45° field of view · diabetic retinopathy graded by the modified Davis classification · NIDEK AFC-230.
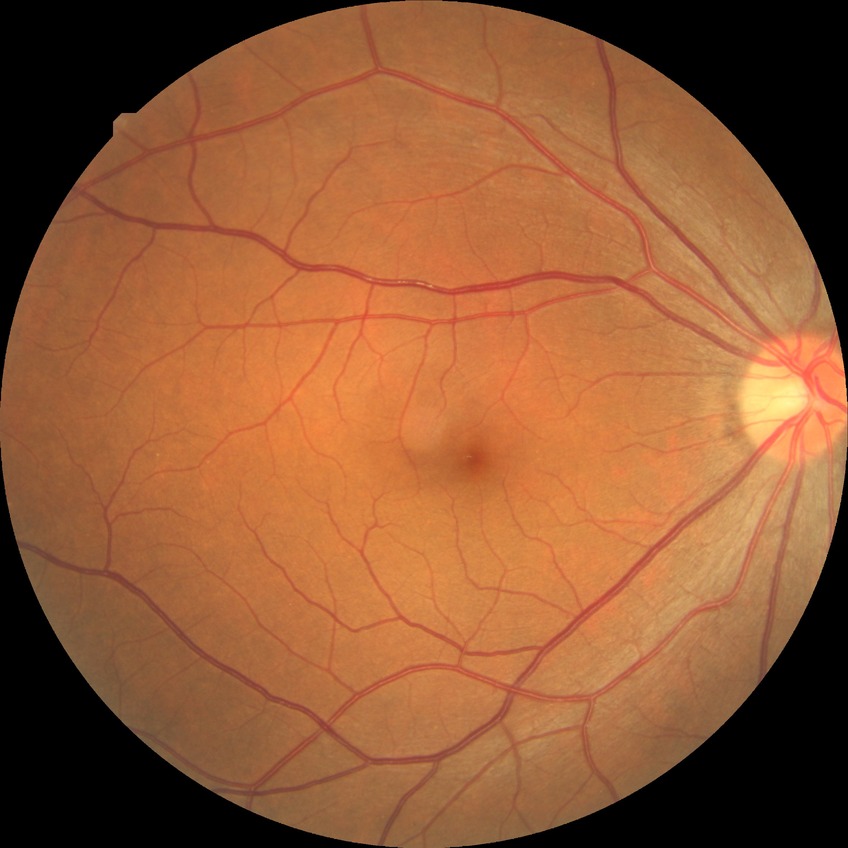 Diabetic retinopathy (DR) is no diabetic retinopathy (NDR).